FOV: 45 degrees:
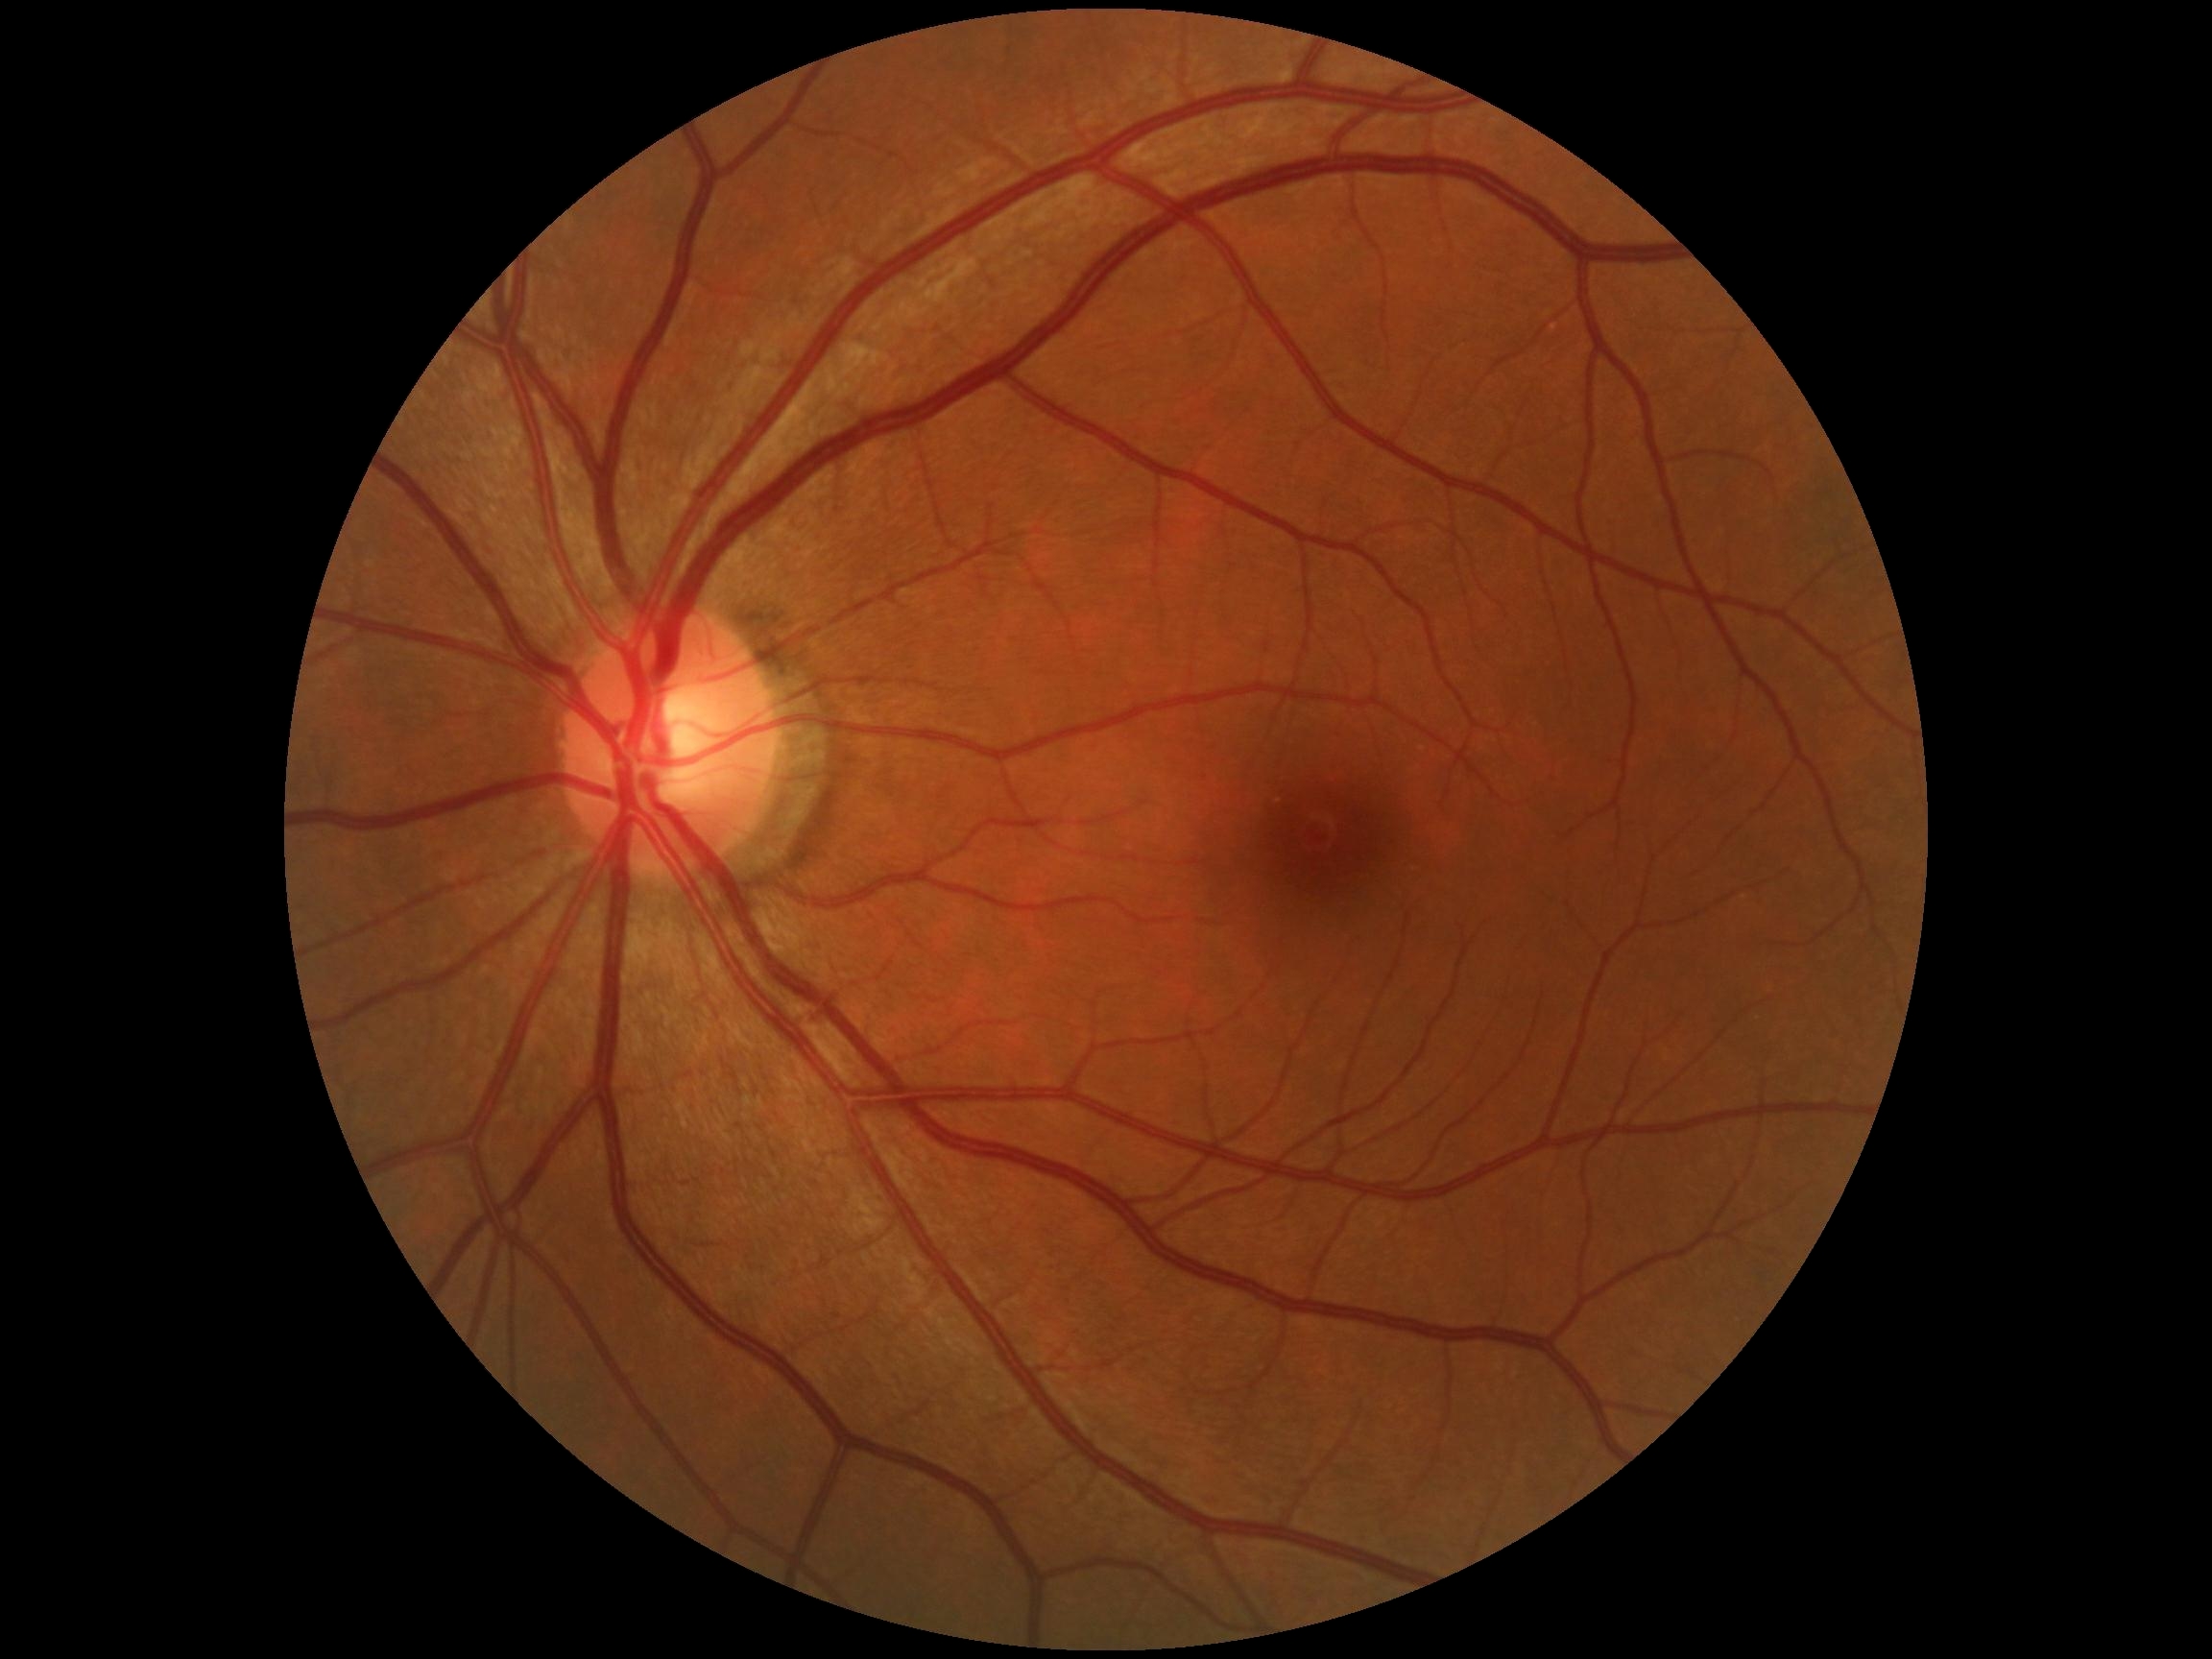

DR impression = no apparent DR
DR stage = grade 0